848x848: 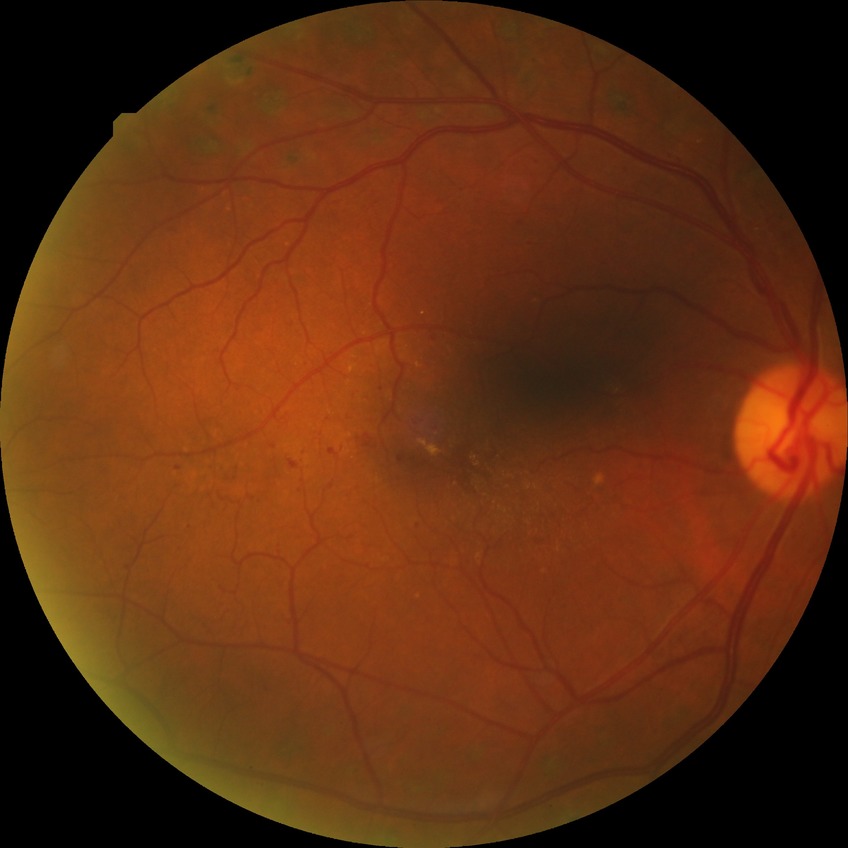
DR stage: PDR.